100° field of view (Phoenix ICON) · wide-field fundus image from infant ROP screening · 1240 x 1240 pixels:
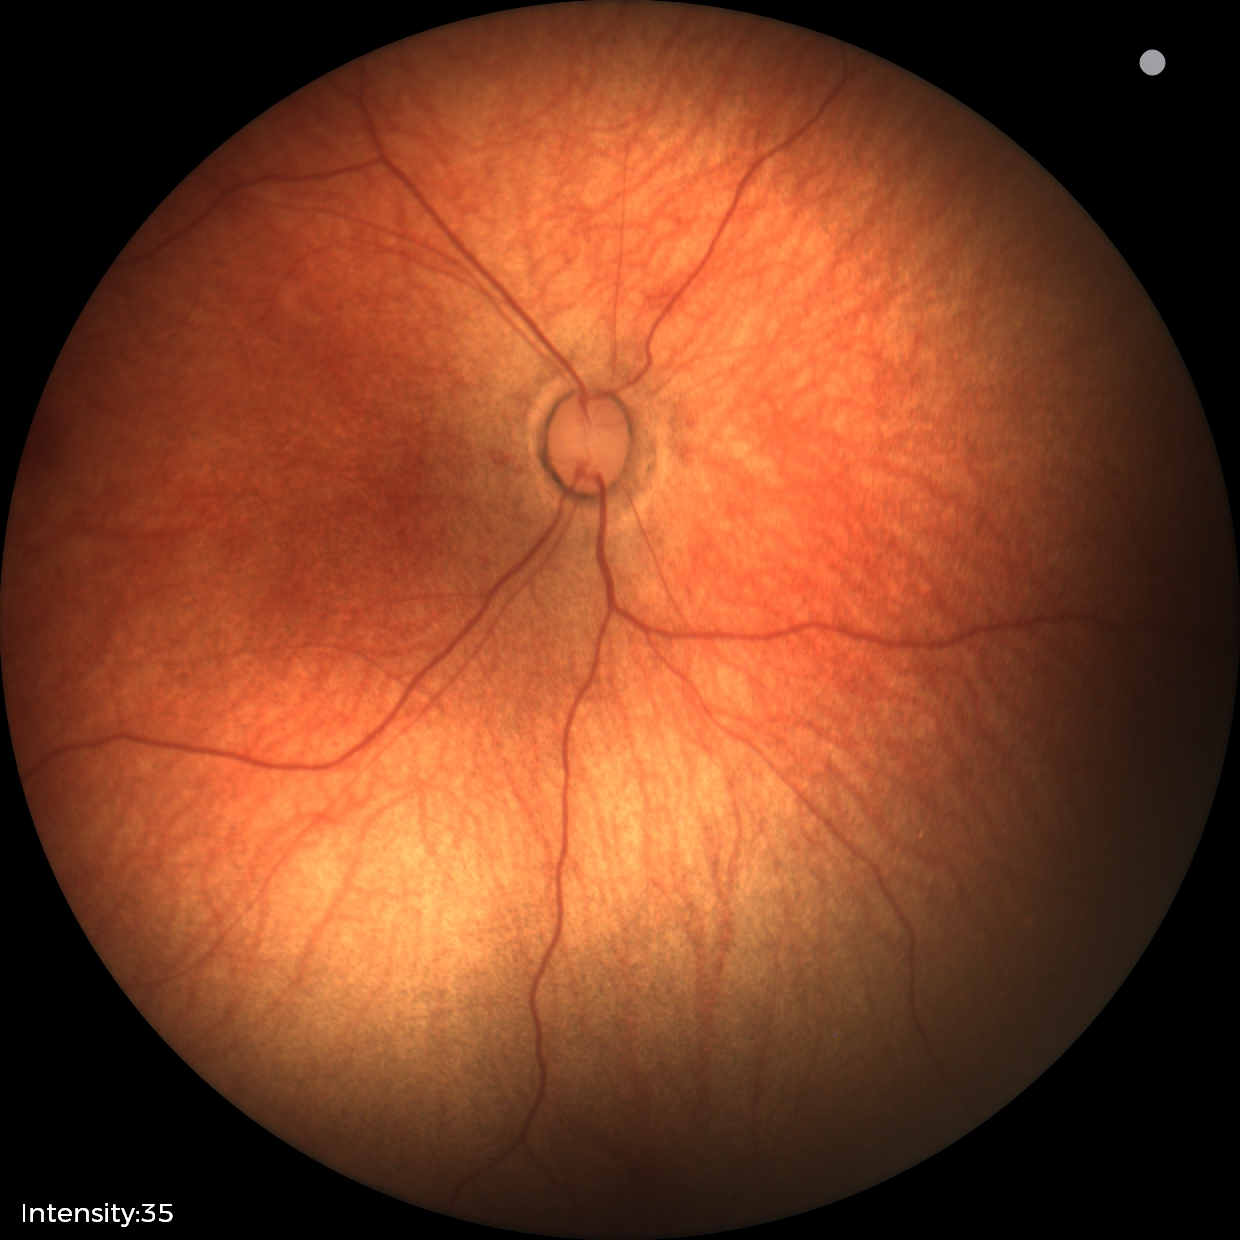

Examination with physiological retinal findings.